Image size 2048x1536; color fundus image; 45-degree field of view — 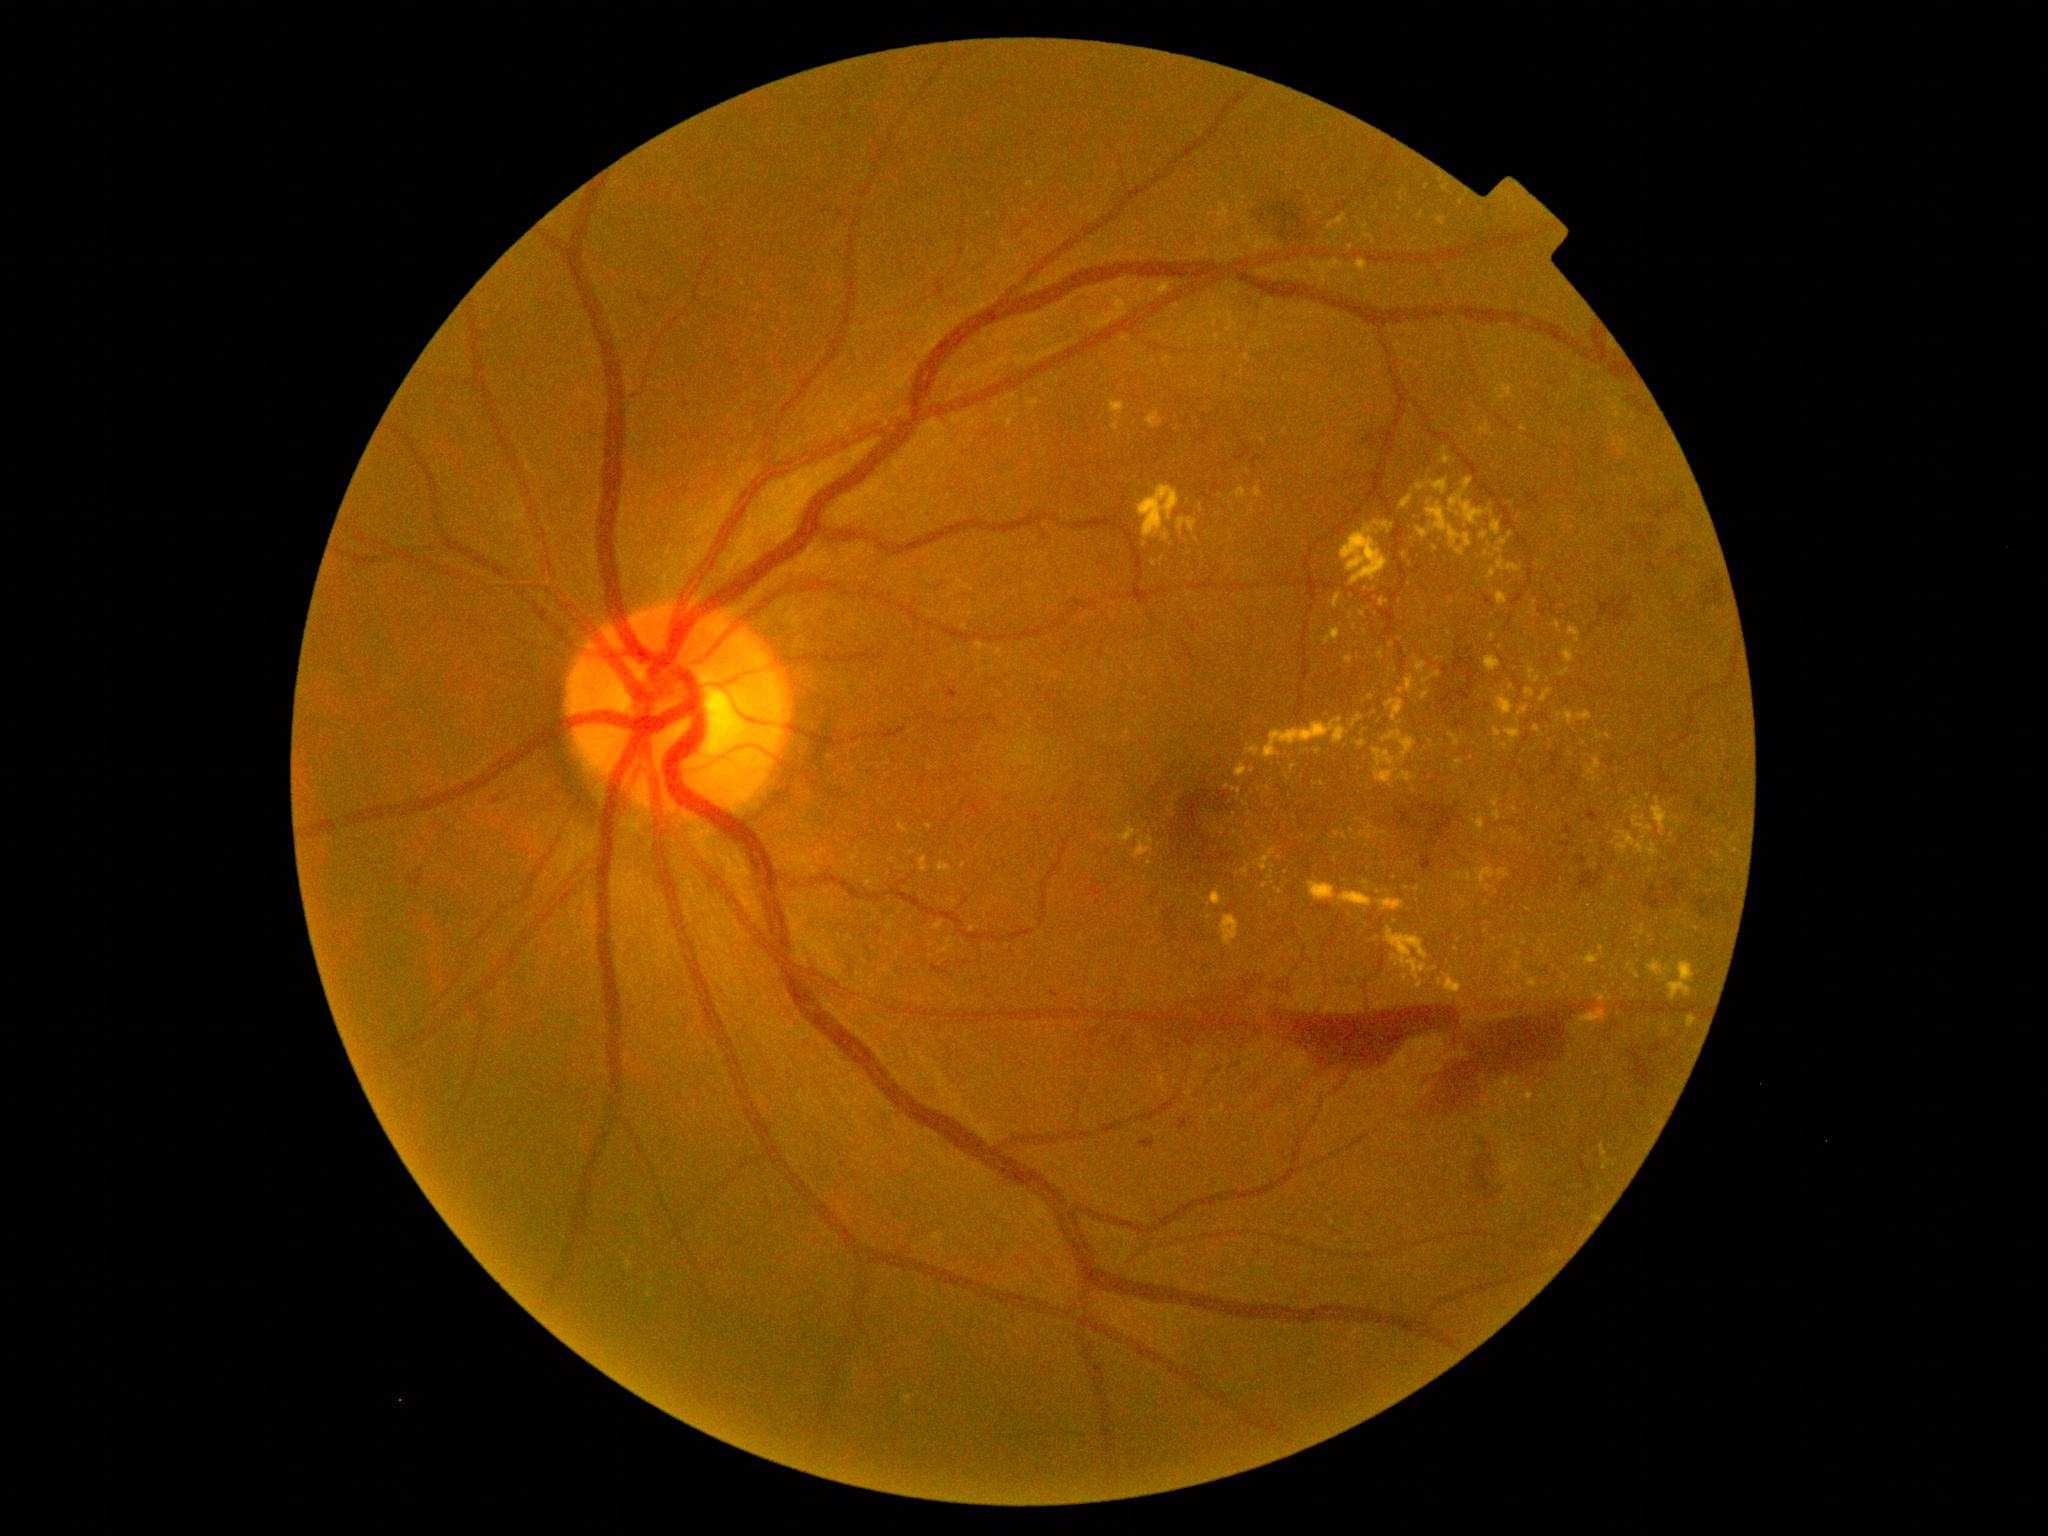 Retinopathy is 4/4
A subset of detected lesions:
• hard exudates (continued): [1618, 832, 1645, 855]; [1406, 676, 1416, 692]; [1433, 480, 1449, 495]; [1237, 488, 1247, 498]; [1648, 961, 1669, 977]; [1417, 528, 1428, 540]; [1493, 812, 1502, 821]; [1380, 599, 1388, 607]
• Smaller hard exudates around Point(1270, 877); Point(1608, 737); Point(1498, 392); Point(1426, 696); Point(1488, 888); Point(1265, 886); Point(1446, 188); Point(1365, 883); Point(972, 930); Point(912, 853)